FOV: 45 degrees:
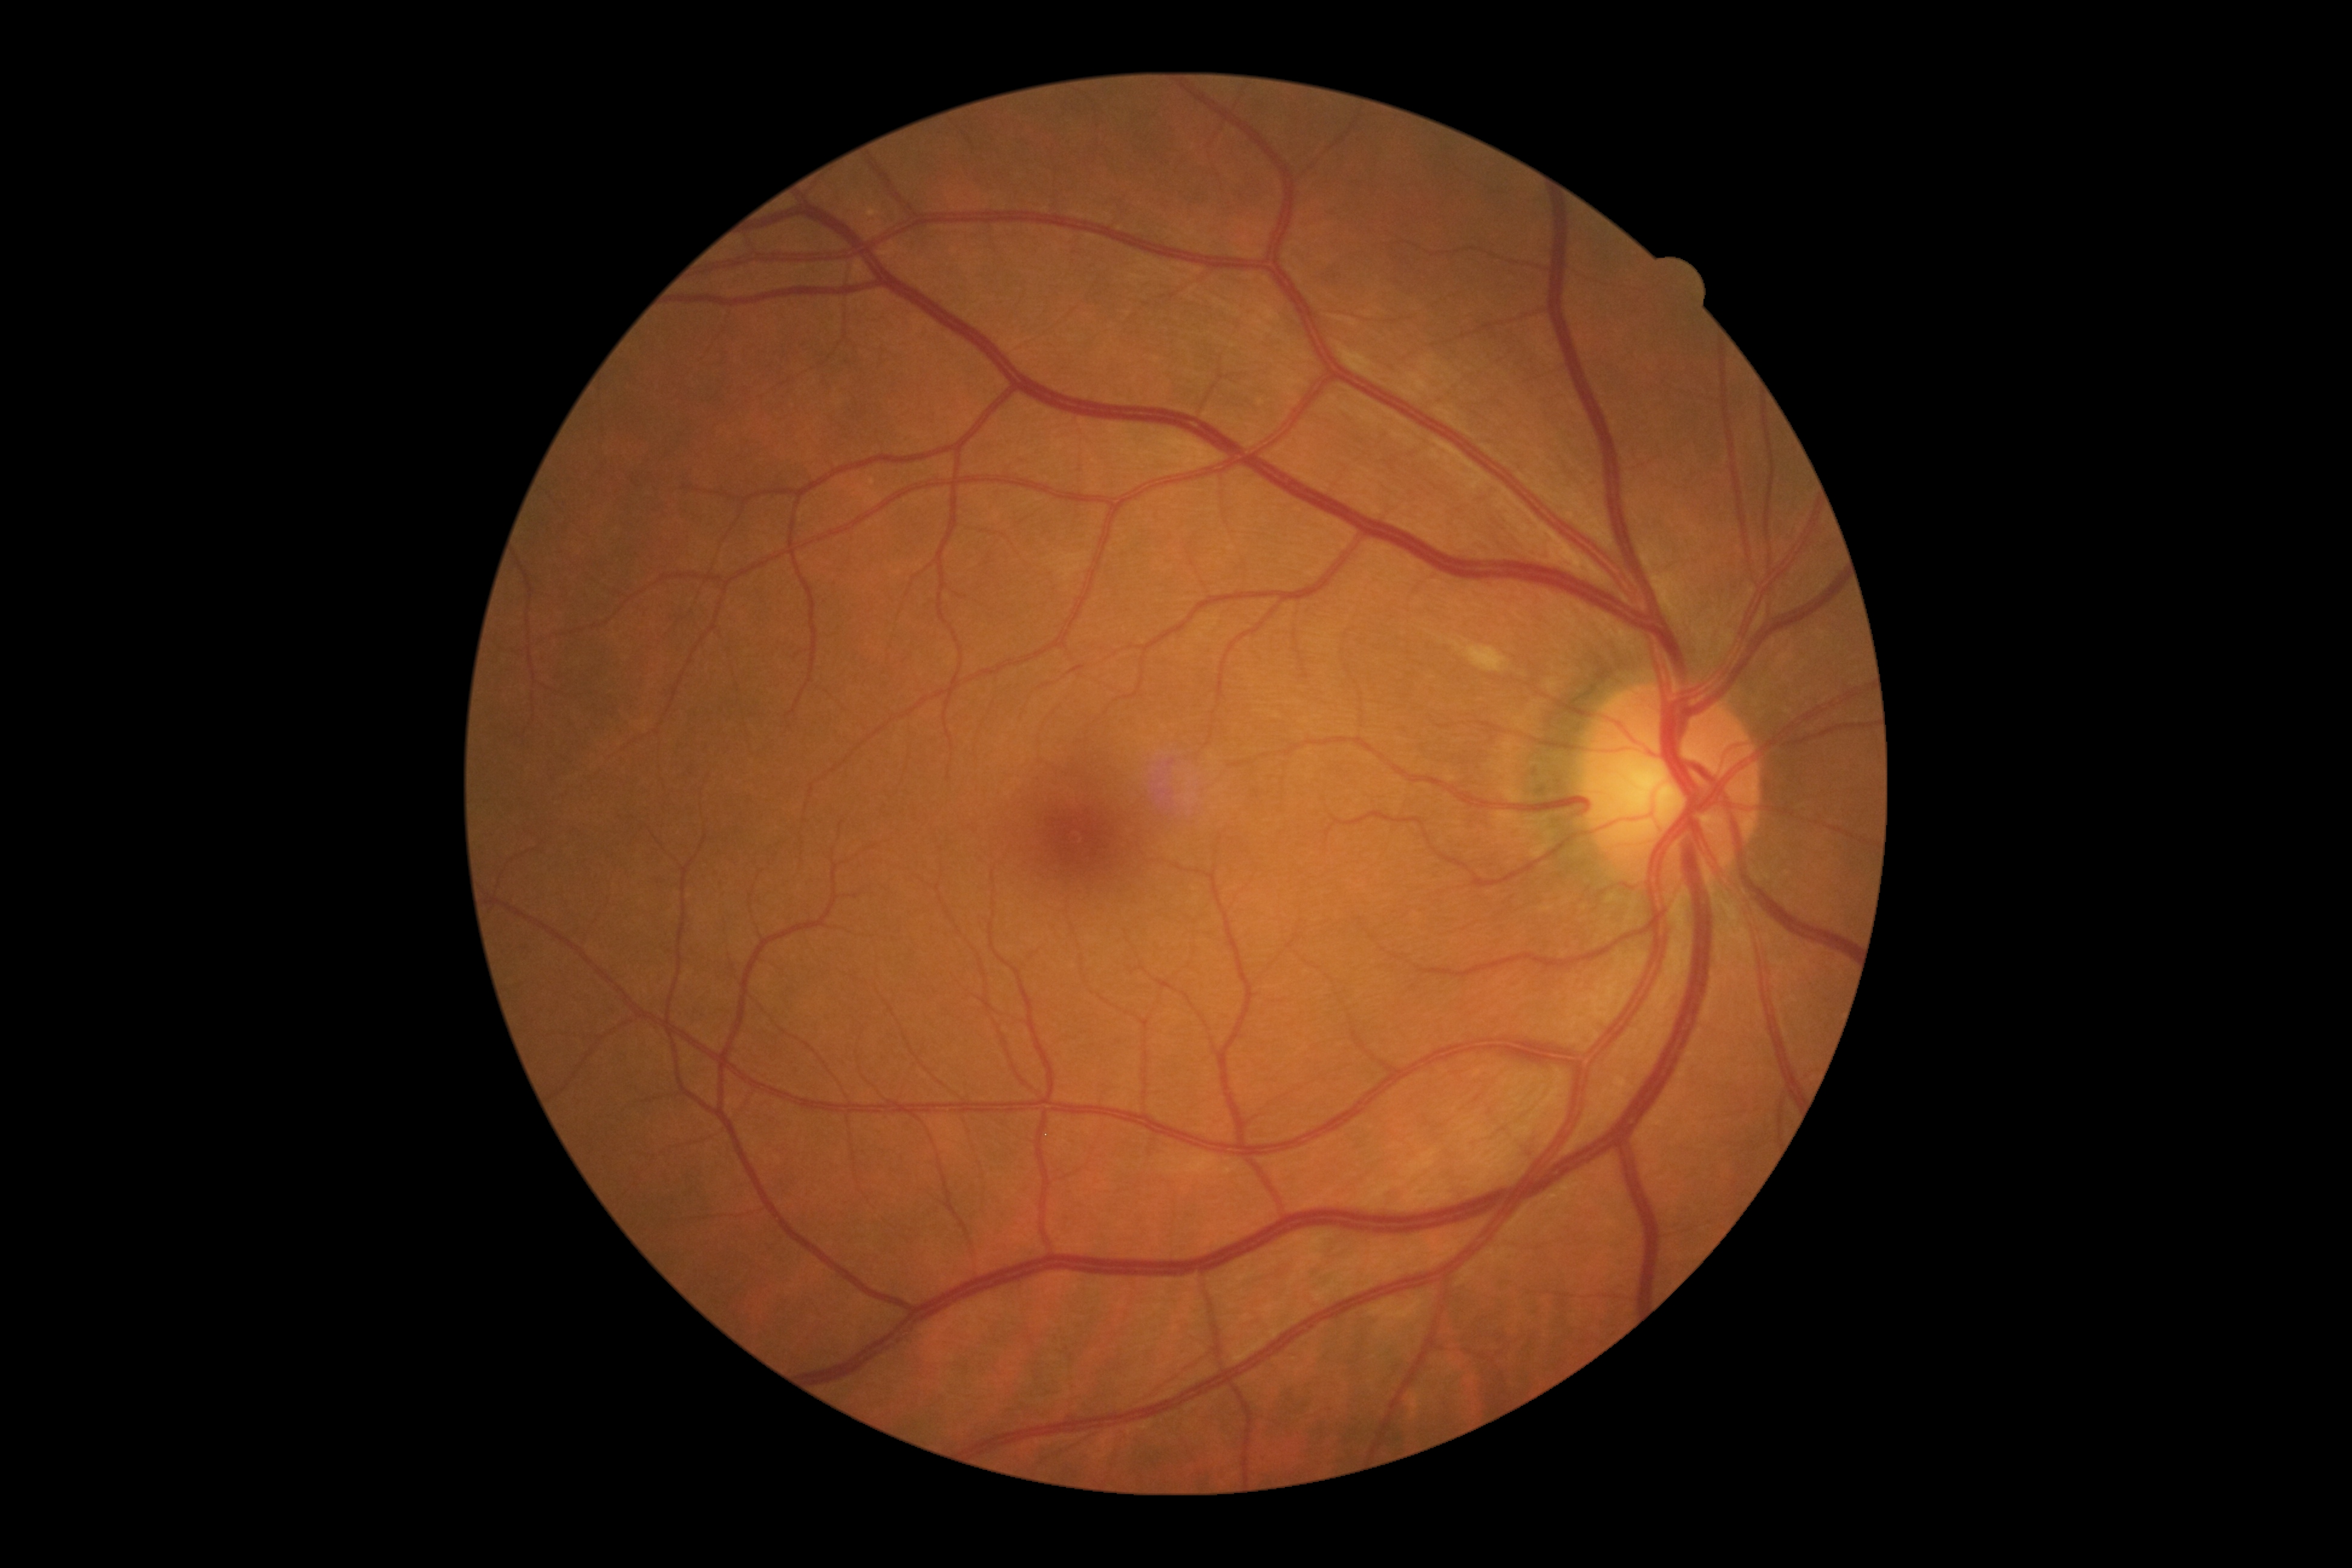

DR = moderate non-proliferative diabetic retinopathy (grade 2).